2352 x 1568 pixels, 45° field of view
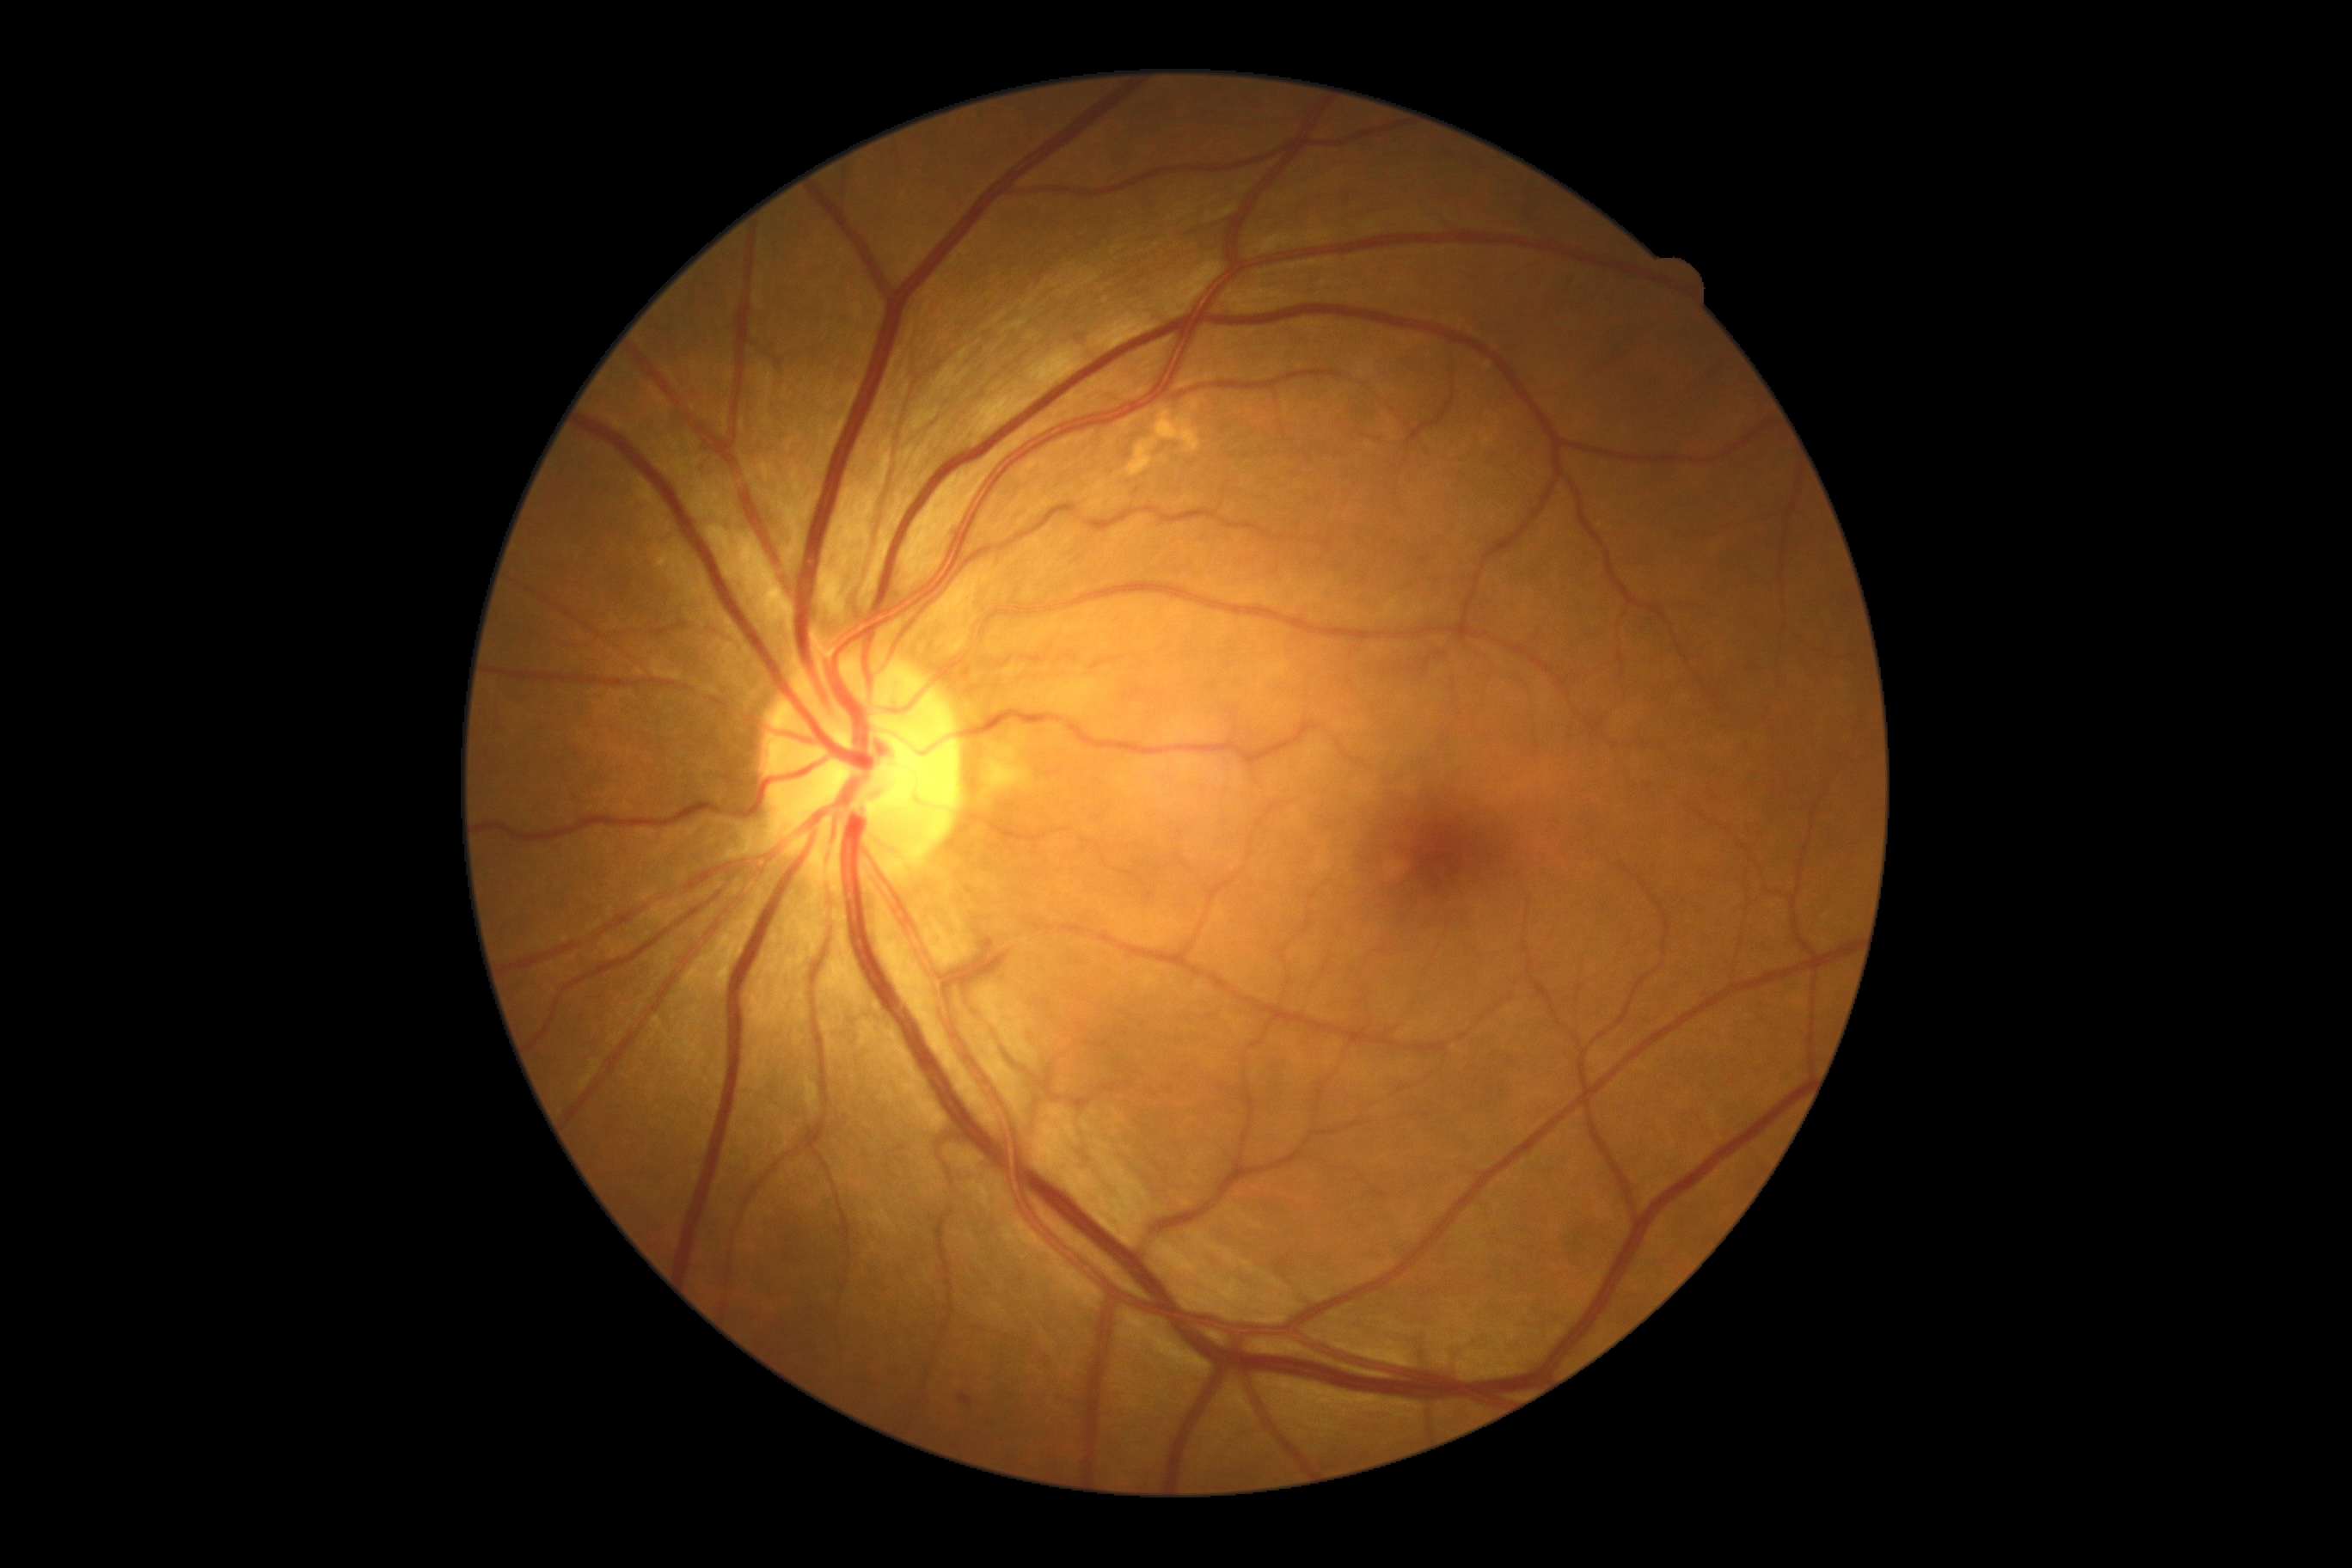

Diabetic retinopathy severity is mild NPDR (grade 1).